45° FOV.
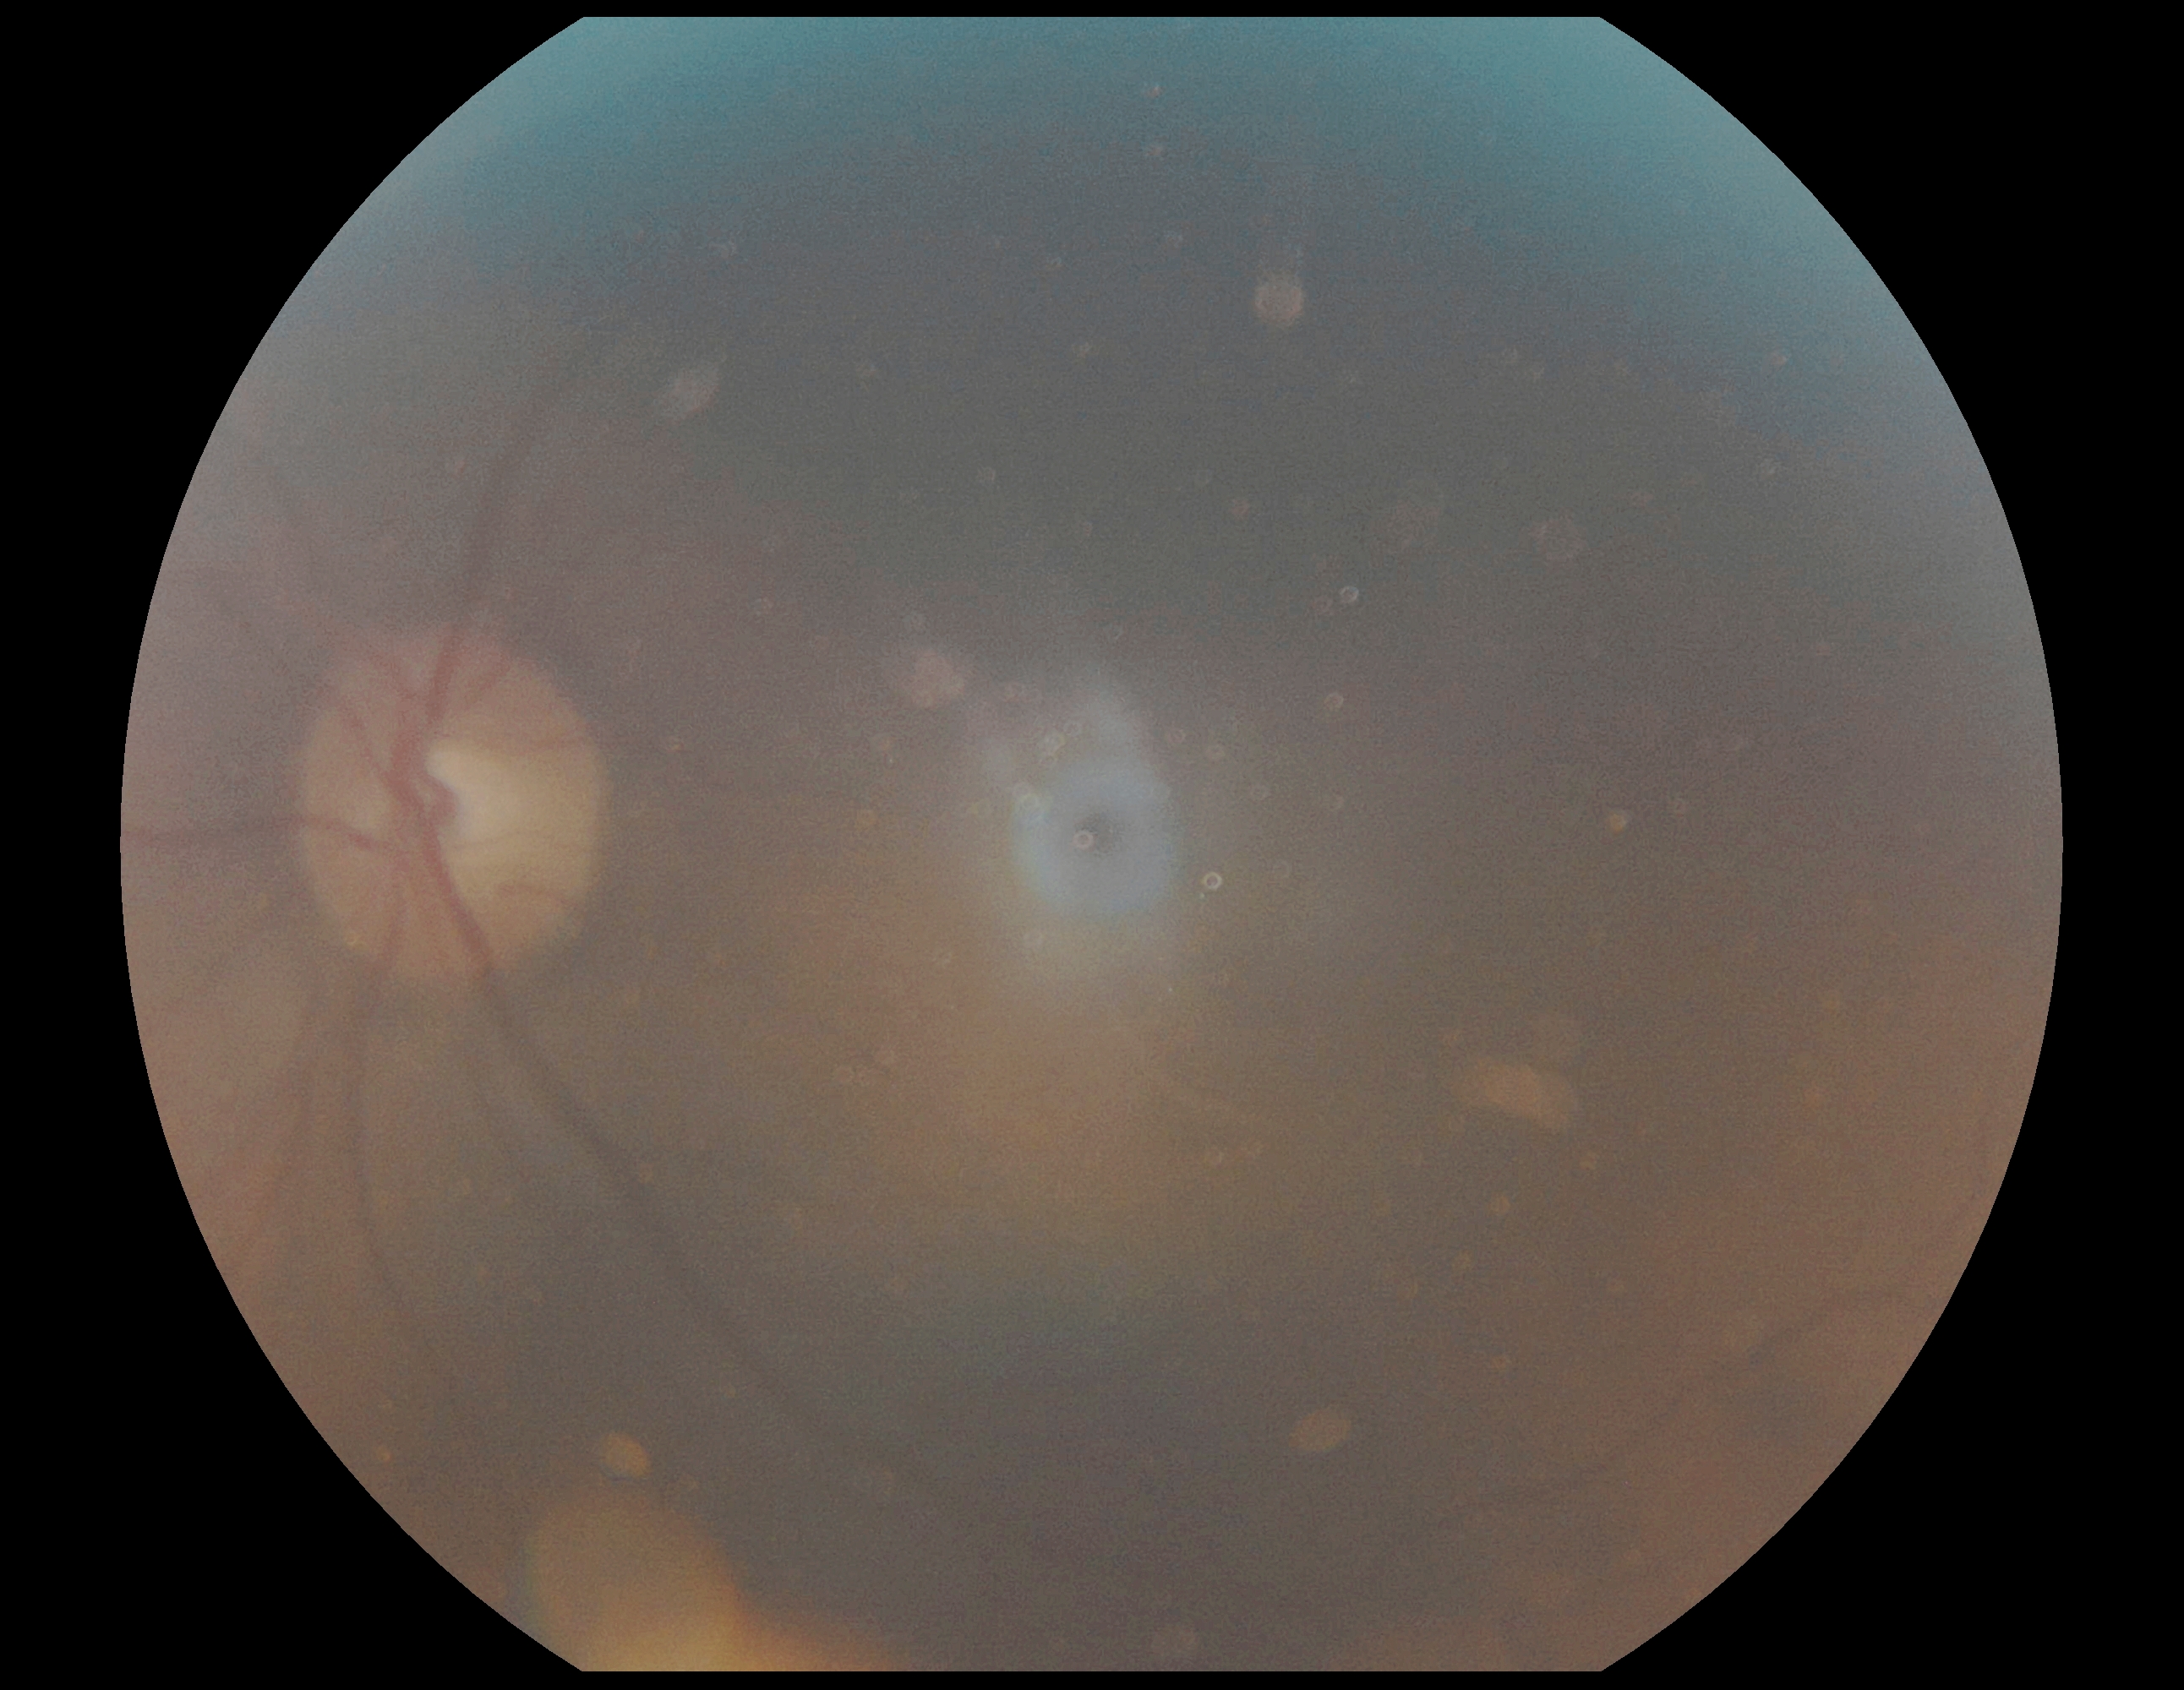 DR severity: ungradable.